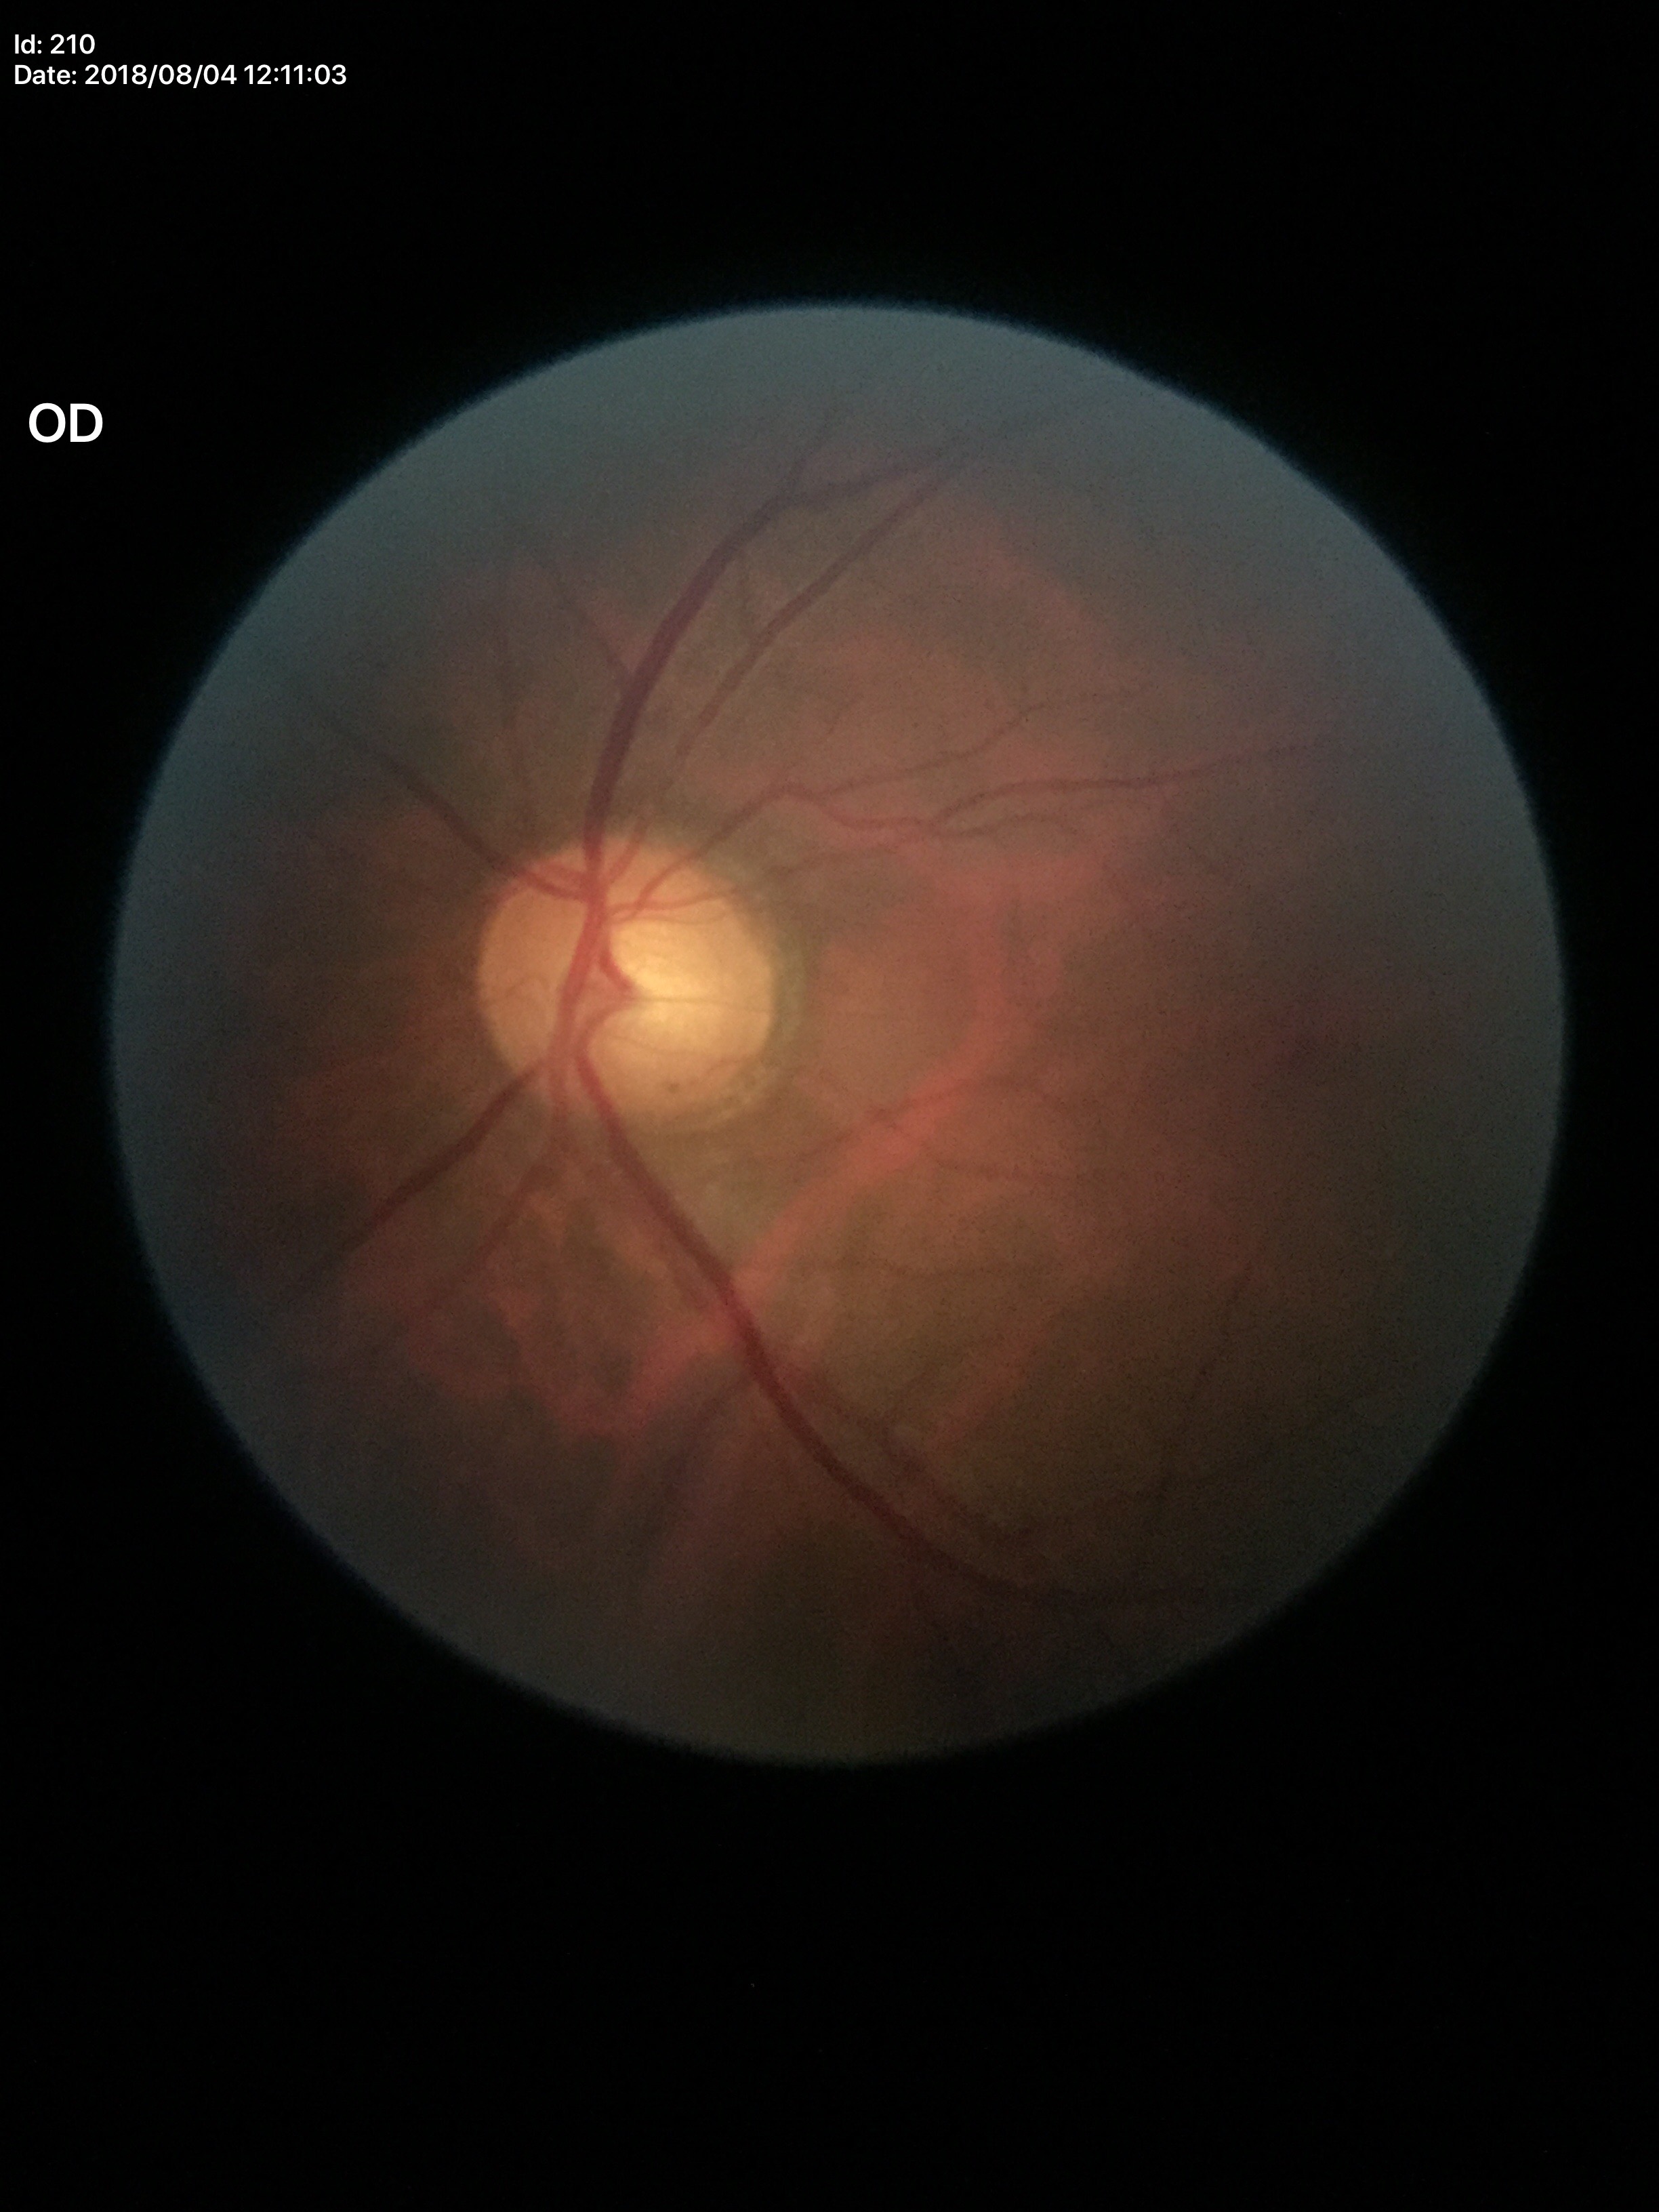 No glaucomatous findings. Vertical cup-to-disc ratio (VCDR) of 0.58.